45° field of view; color fundus image — 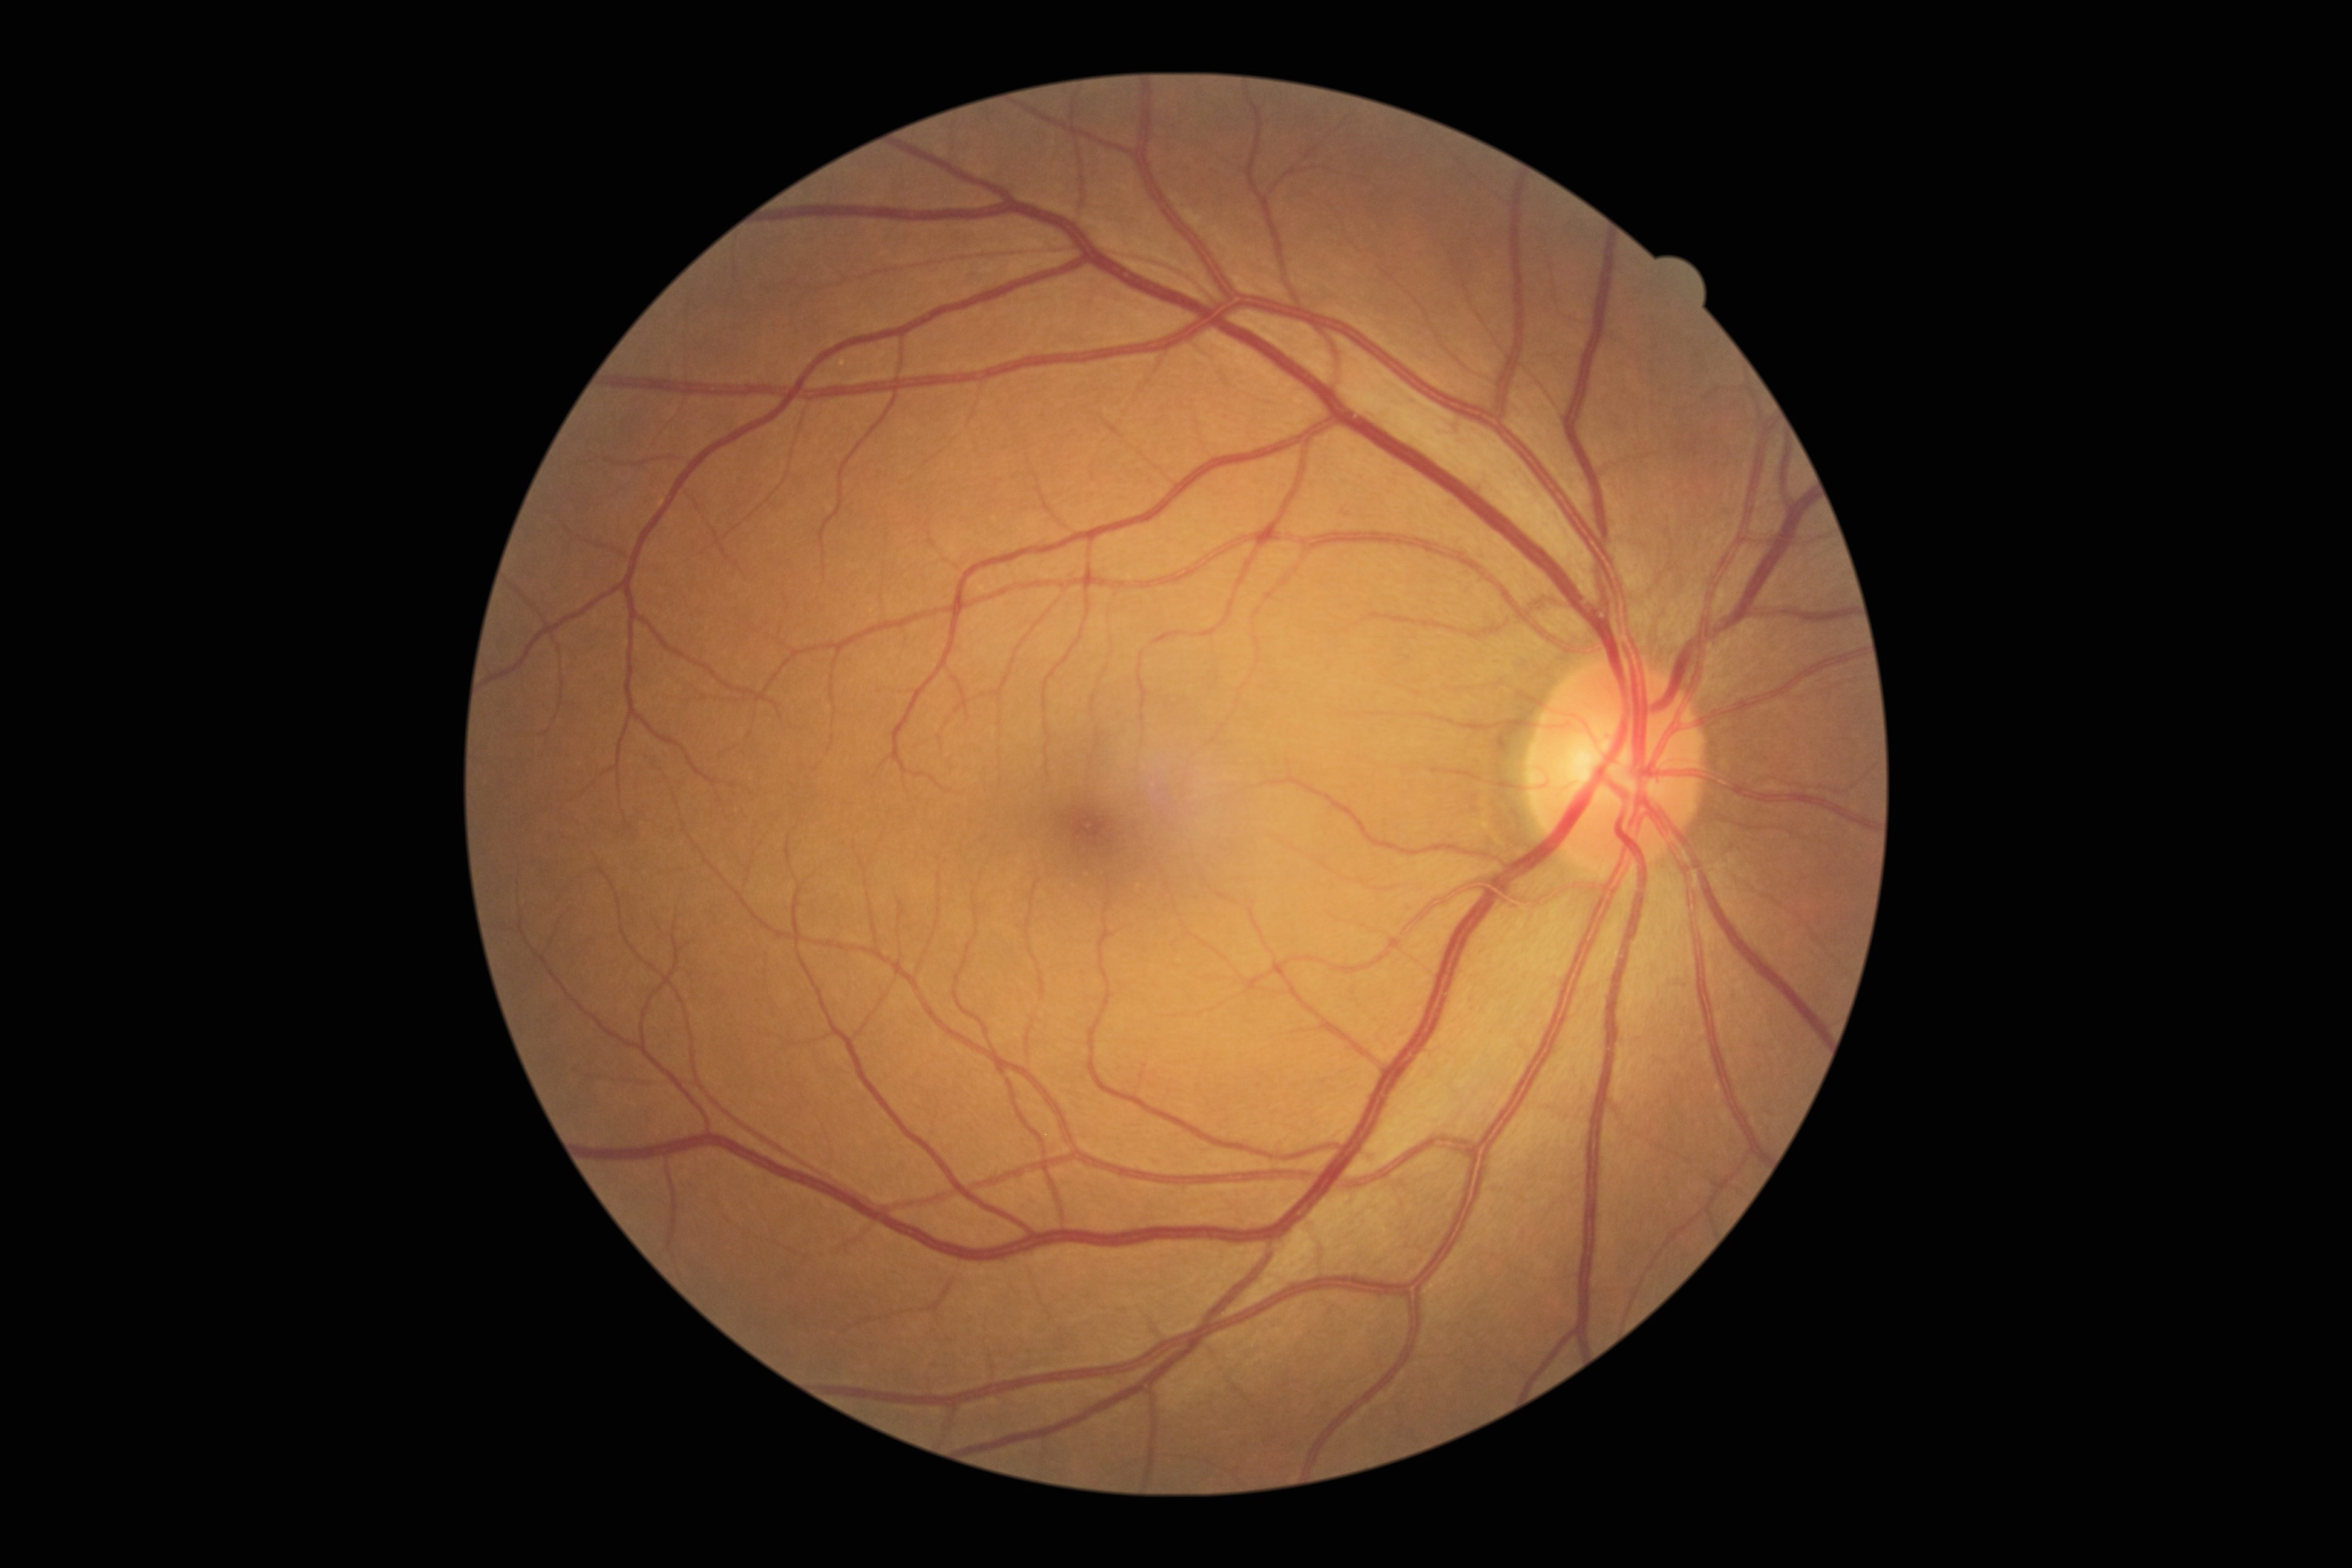 Retinopathy: 0/4 — no visible signs of diabetic retinopathy. No signs of diabetic retinopathy.